CFP; FOV: 45 degrees:
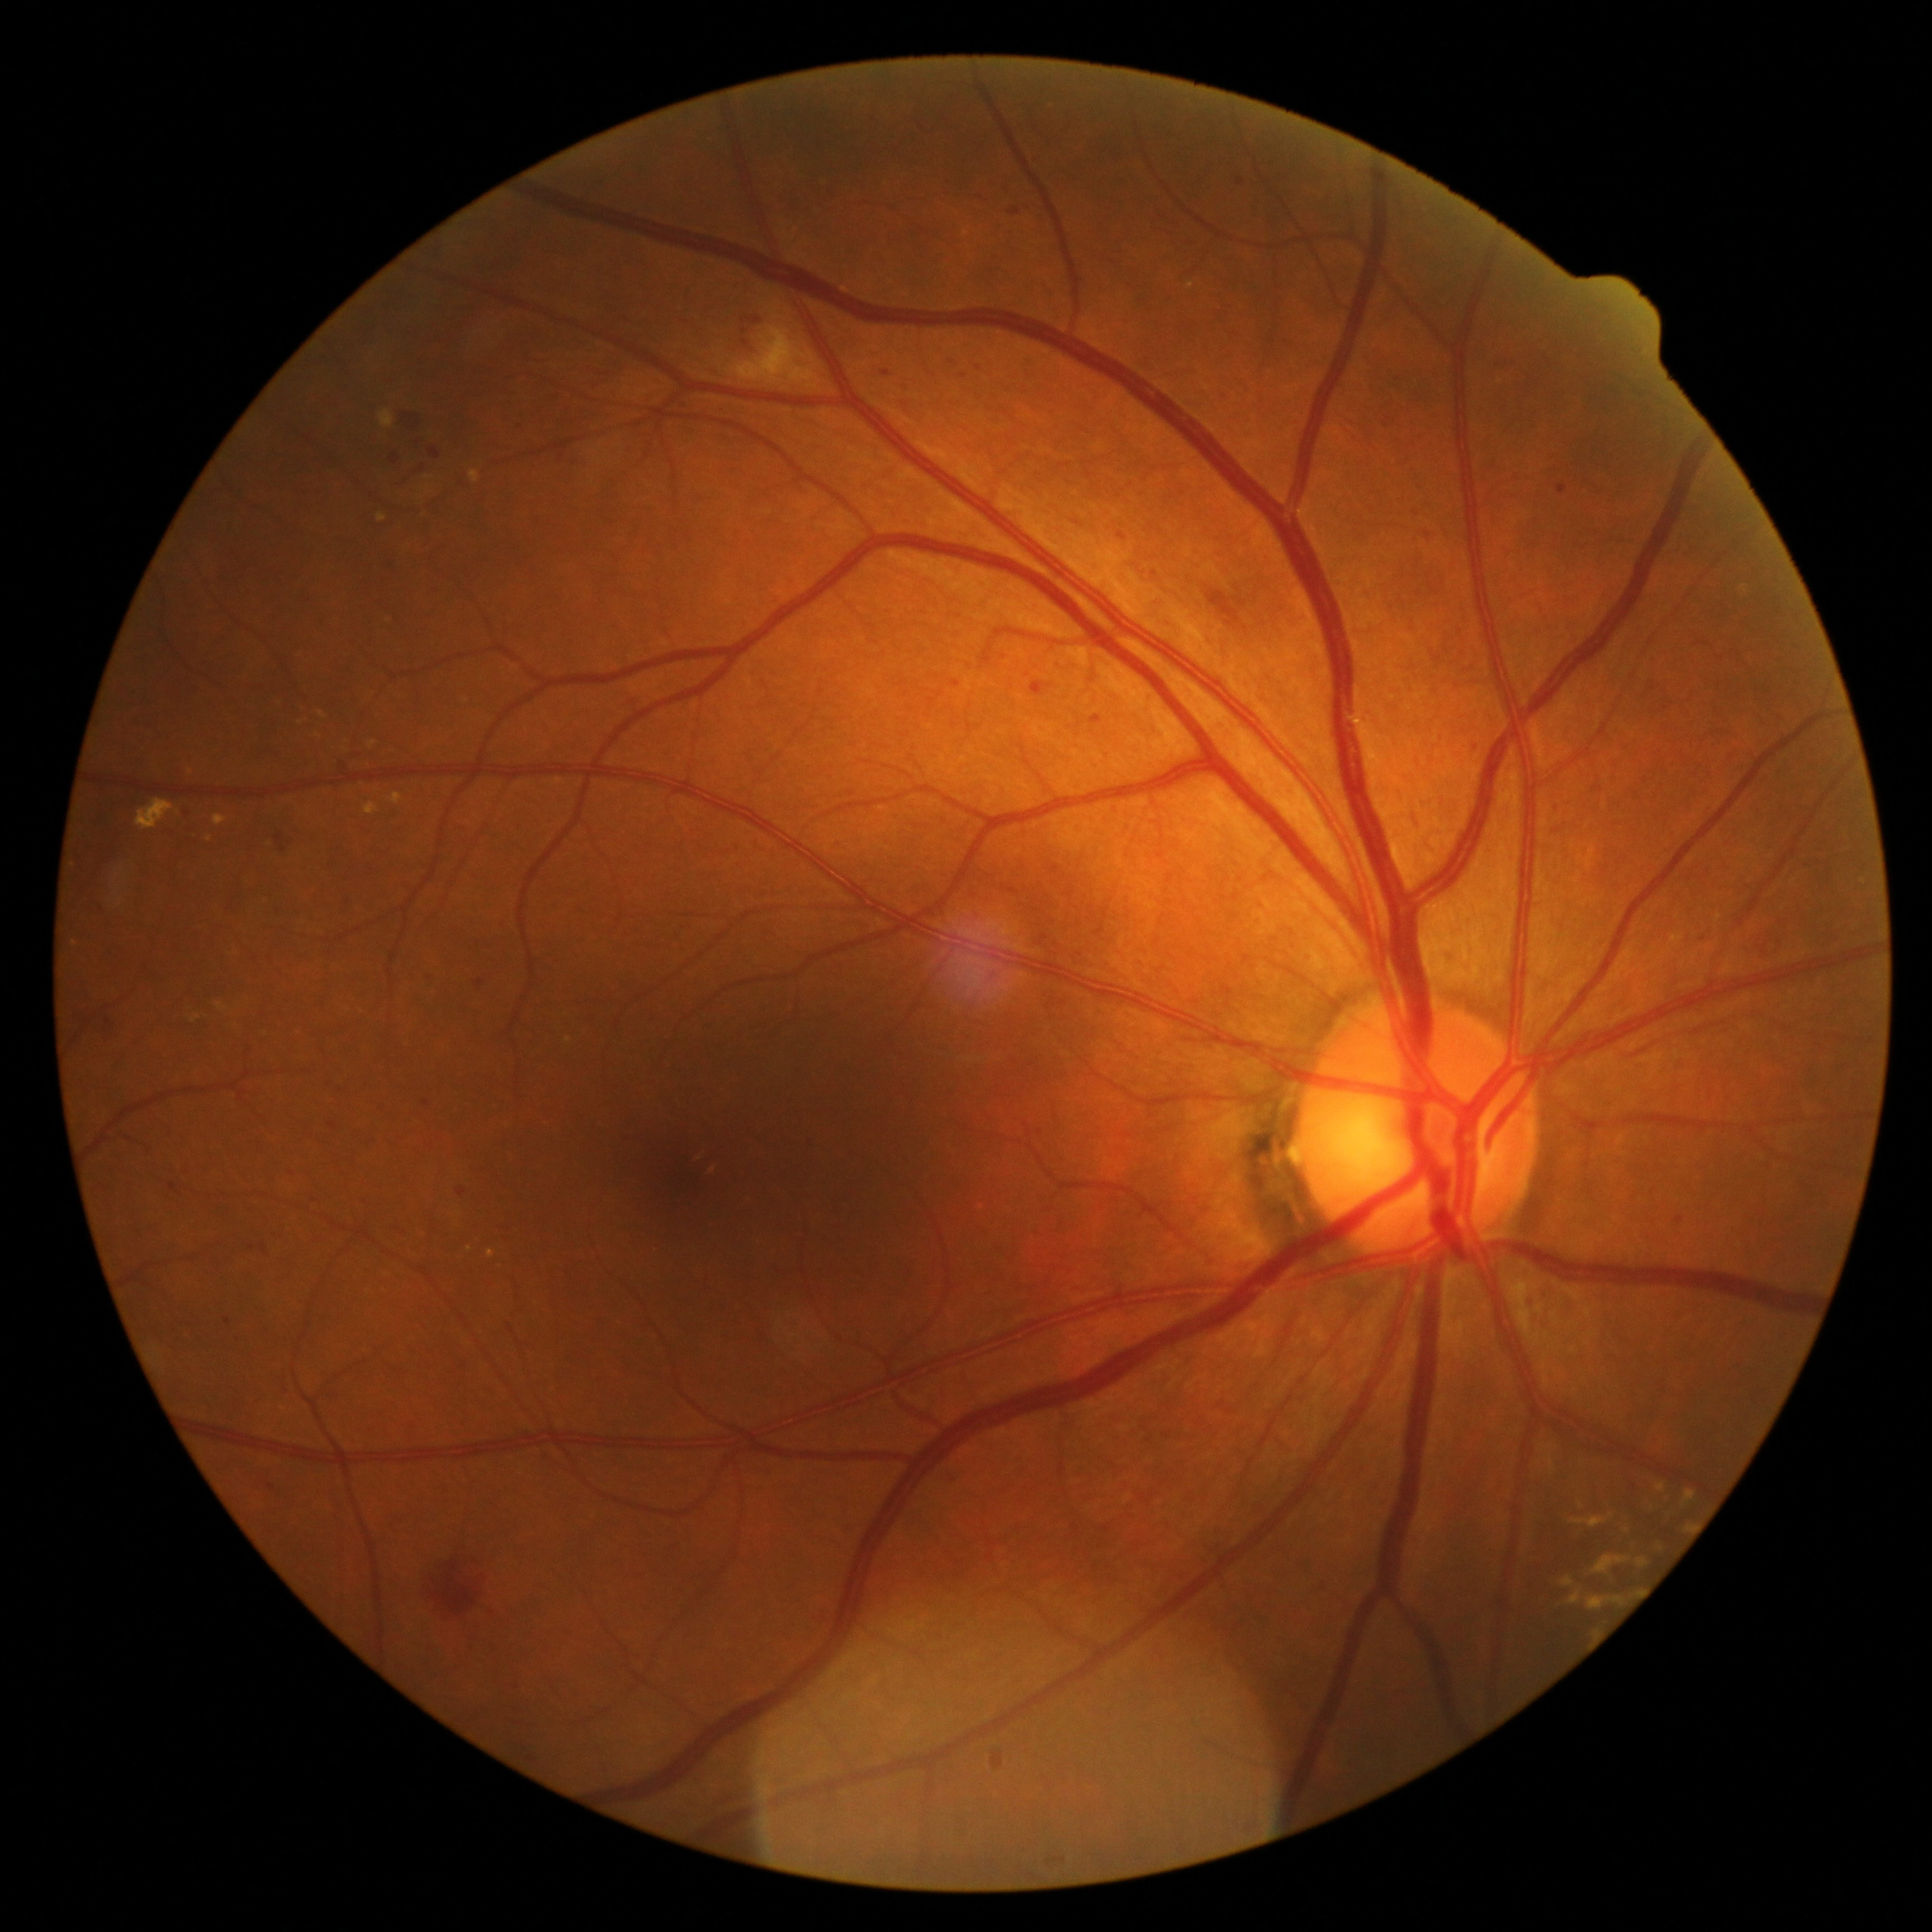 diabetic retinopathy (DR): 2